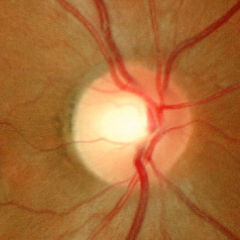

No glaucoma.